45° field of view — 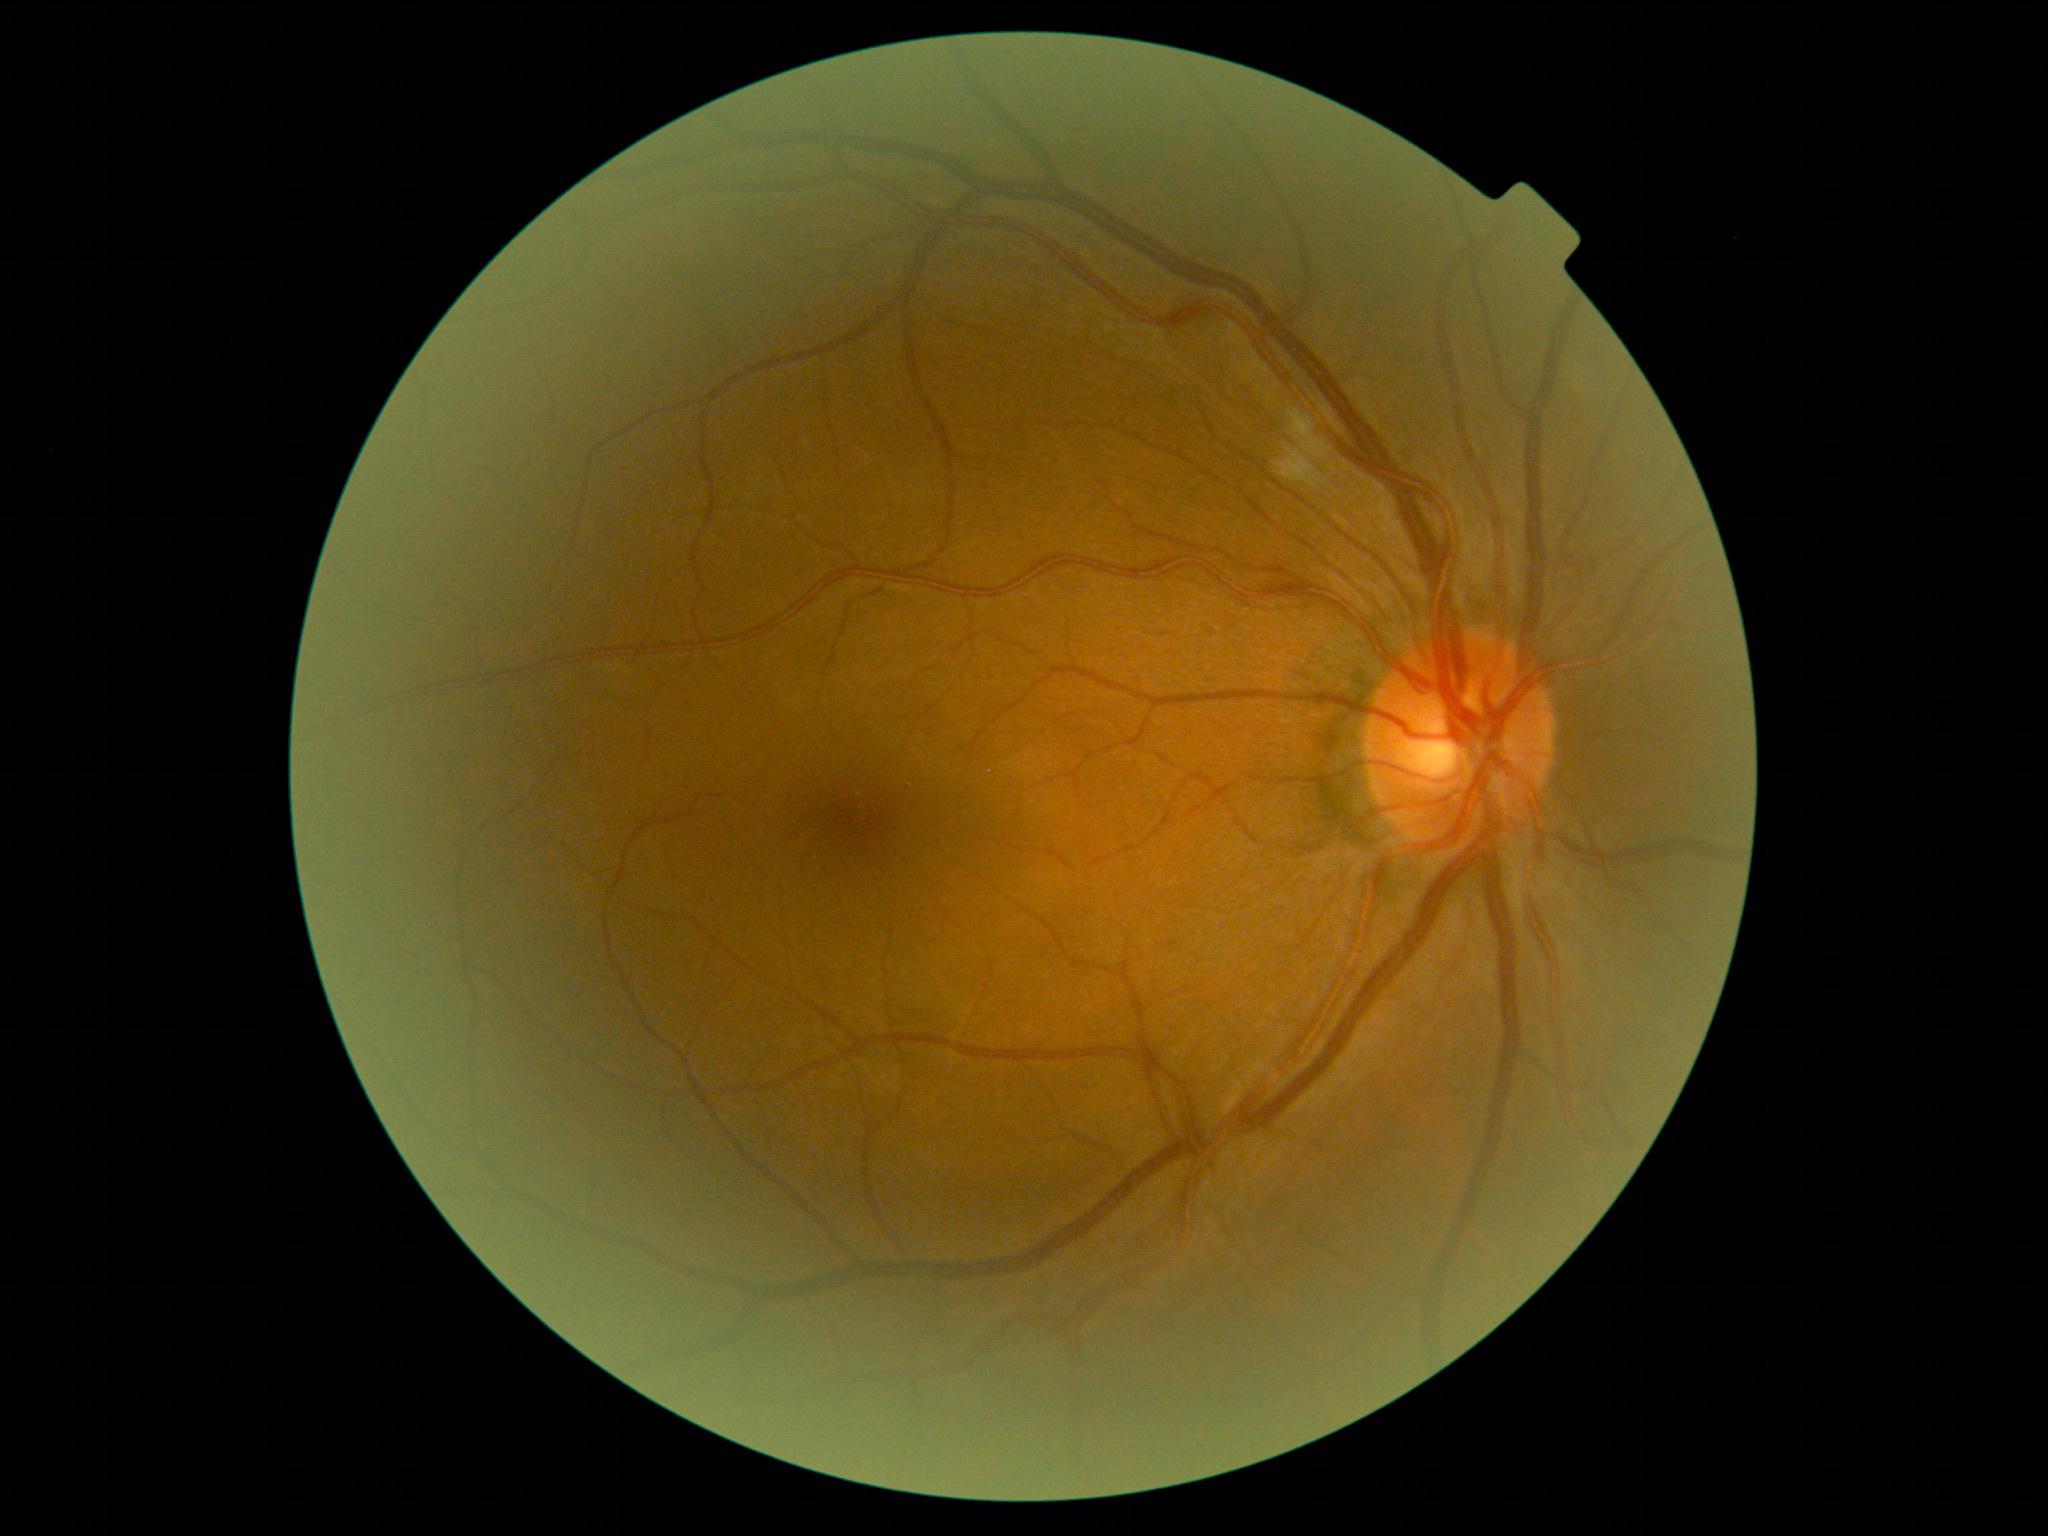
Diabetic retinopathy (DR) is moderate non-proliferative diabetic retinopathy (grade 2).